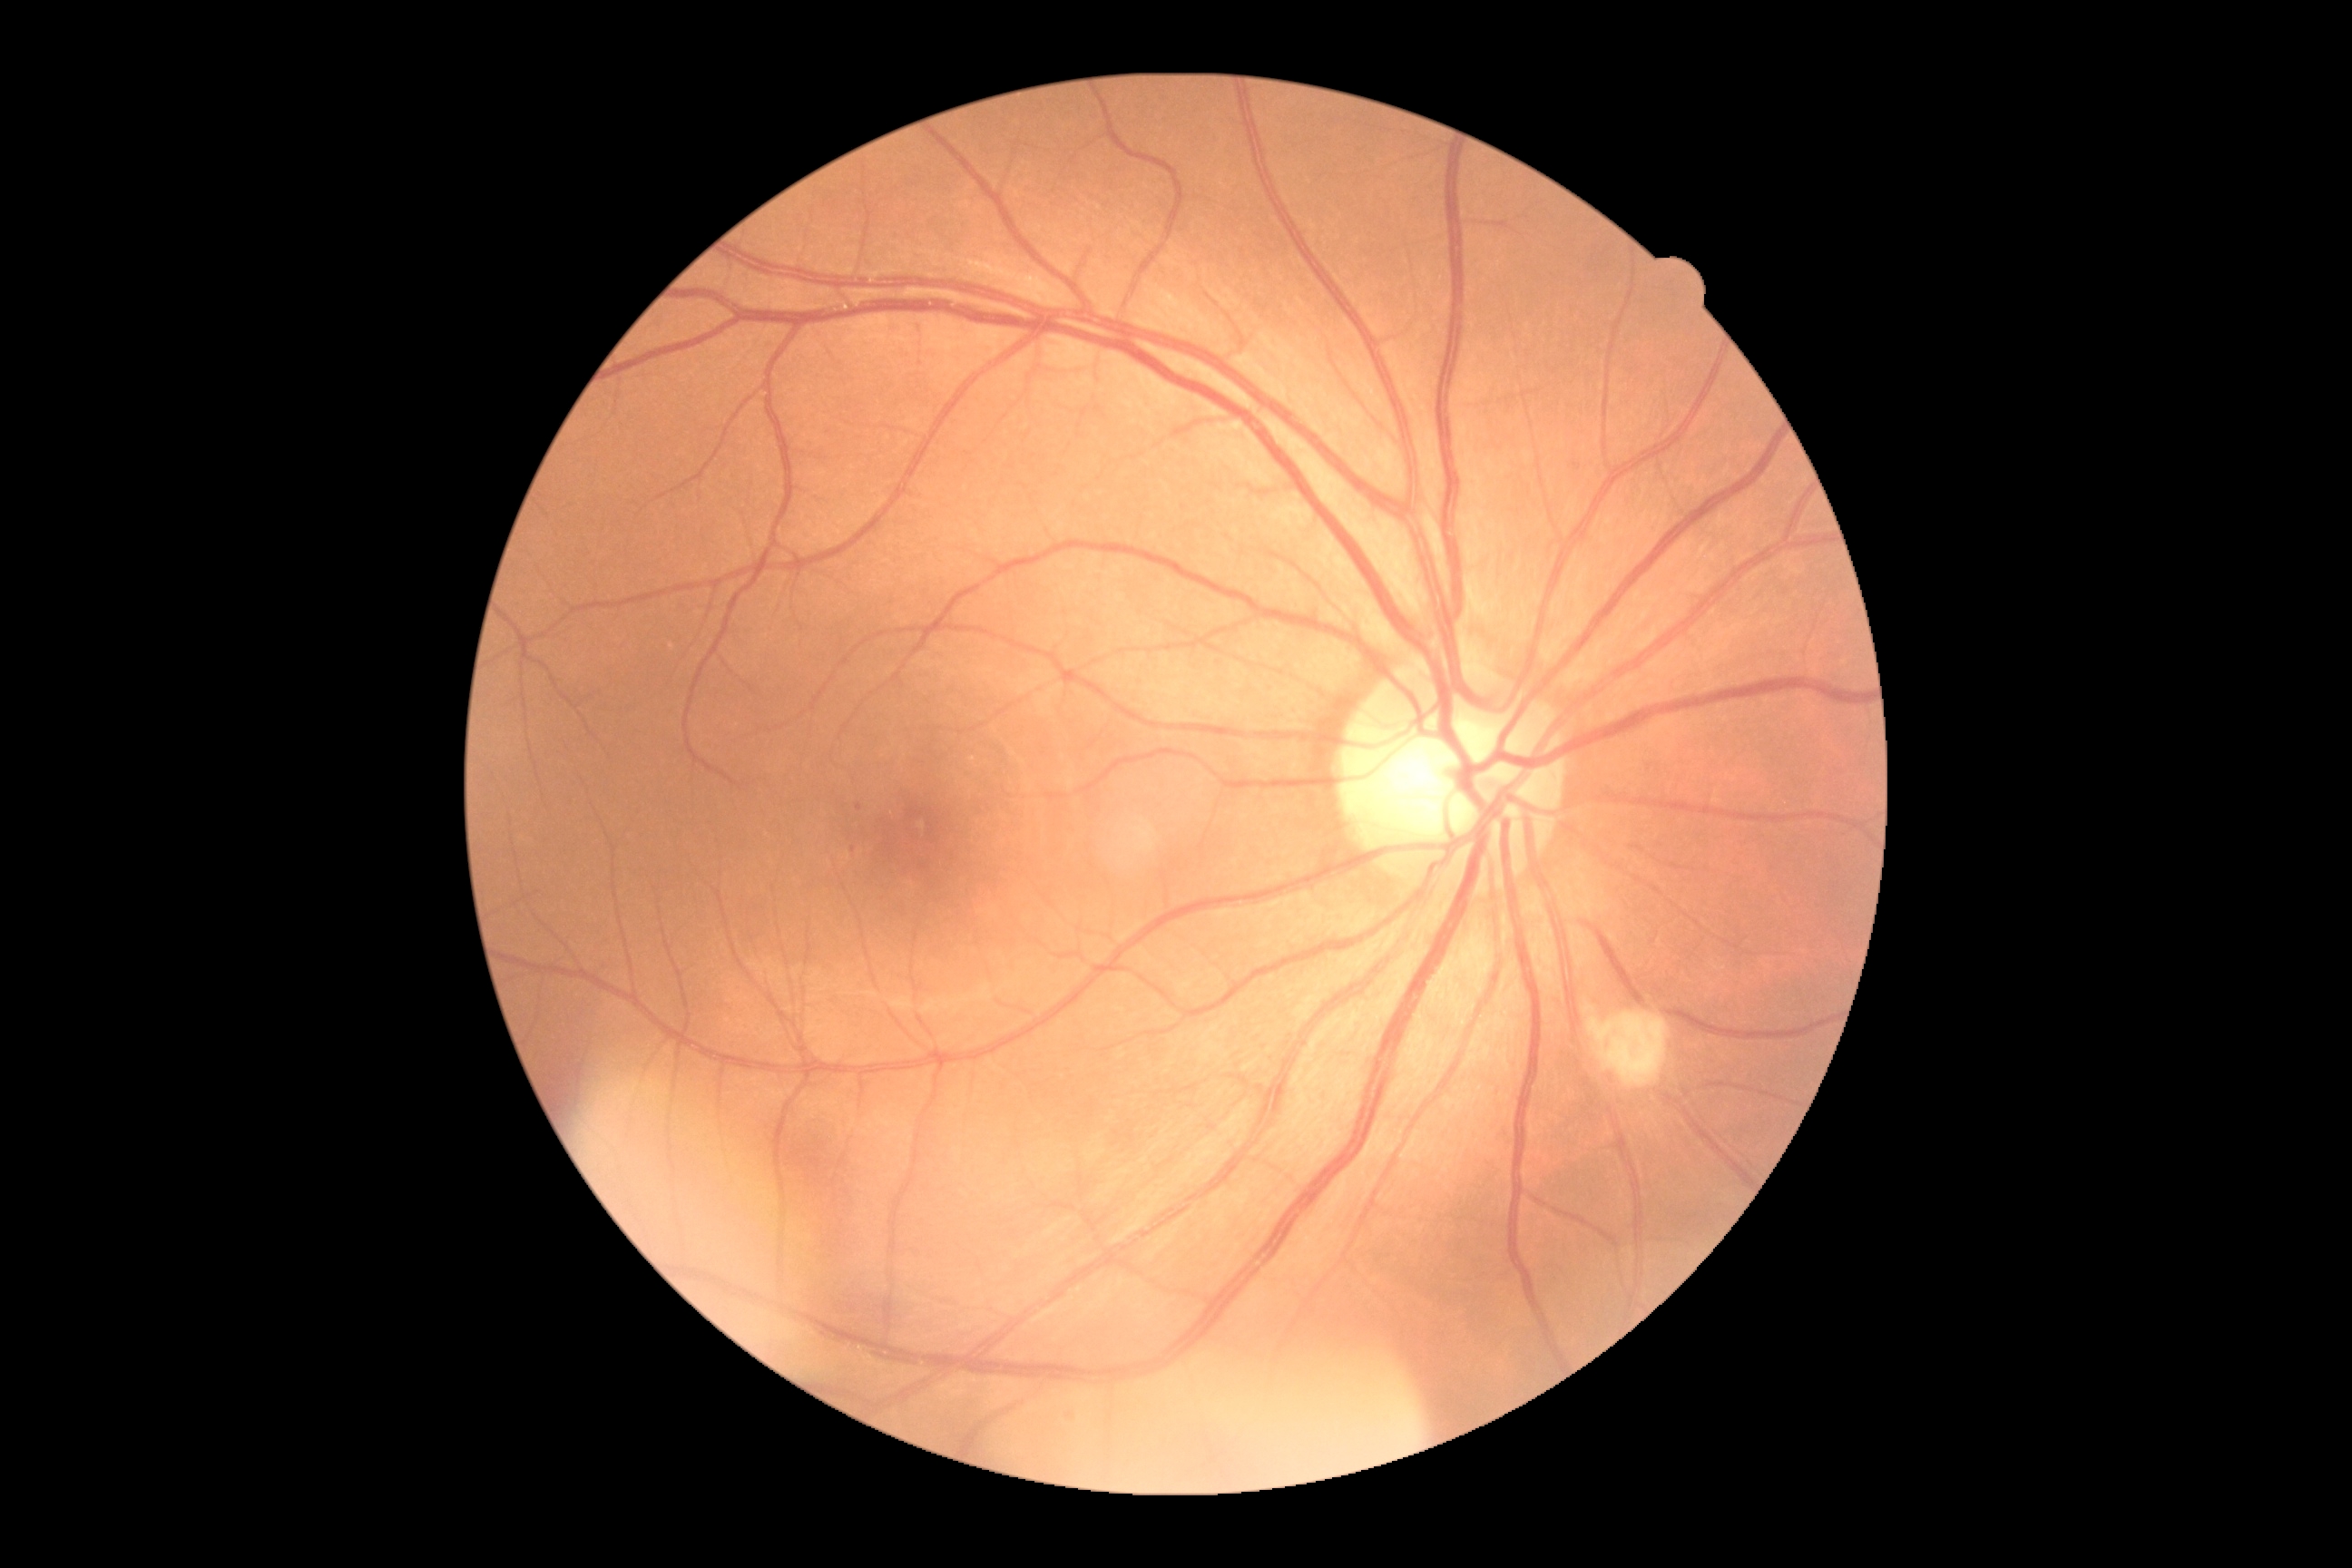 diabetic retinopathy: grade 2 (moderate NPDR)
DR class: non-proliferative diabetic retinopathy